Modified Davis classification:
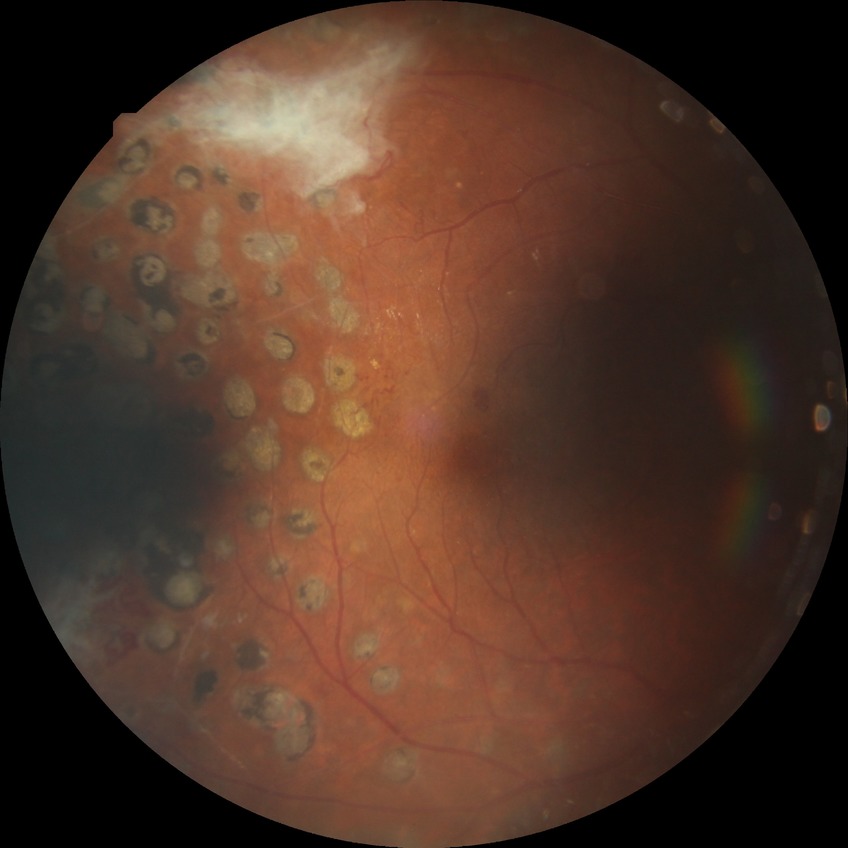 Diabetic retinopathy stage: proliferative diabetic retinopathy.